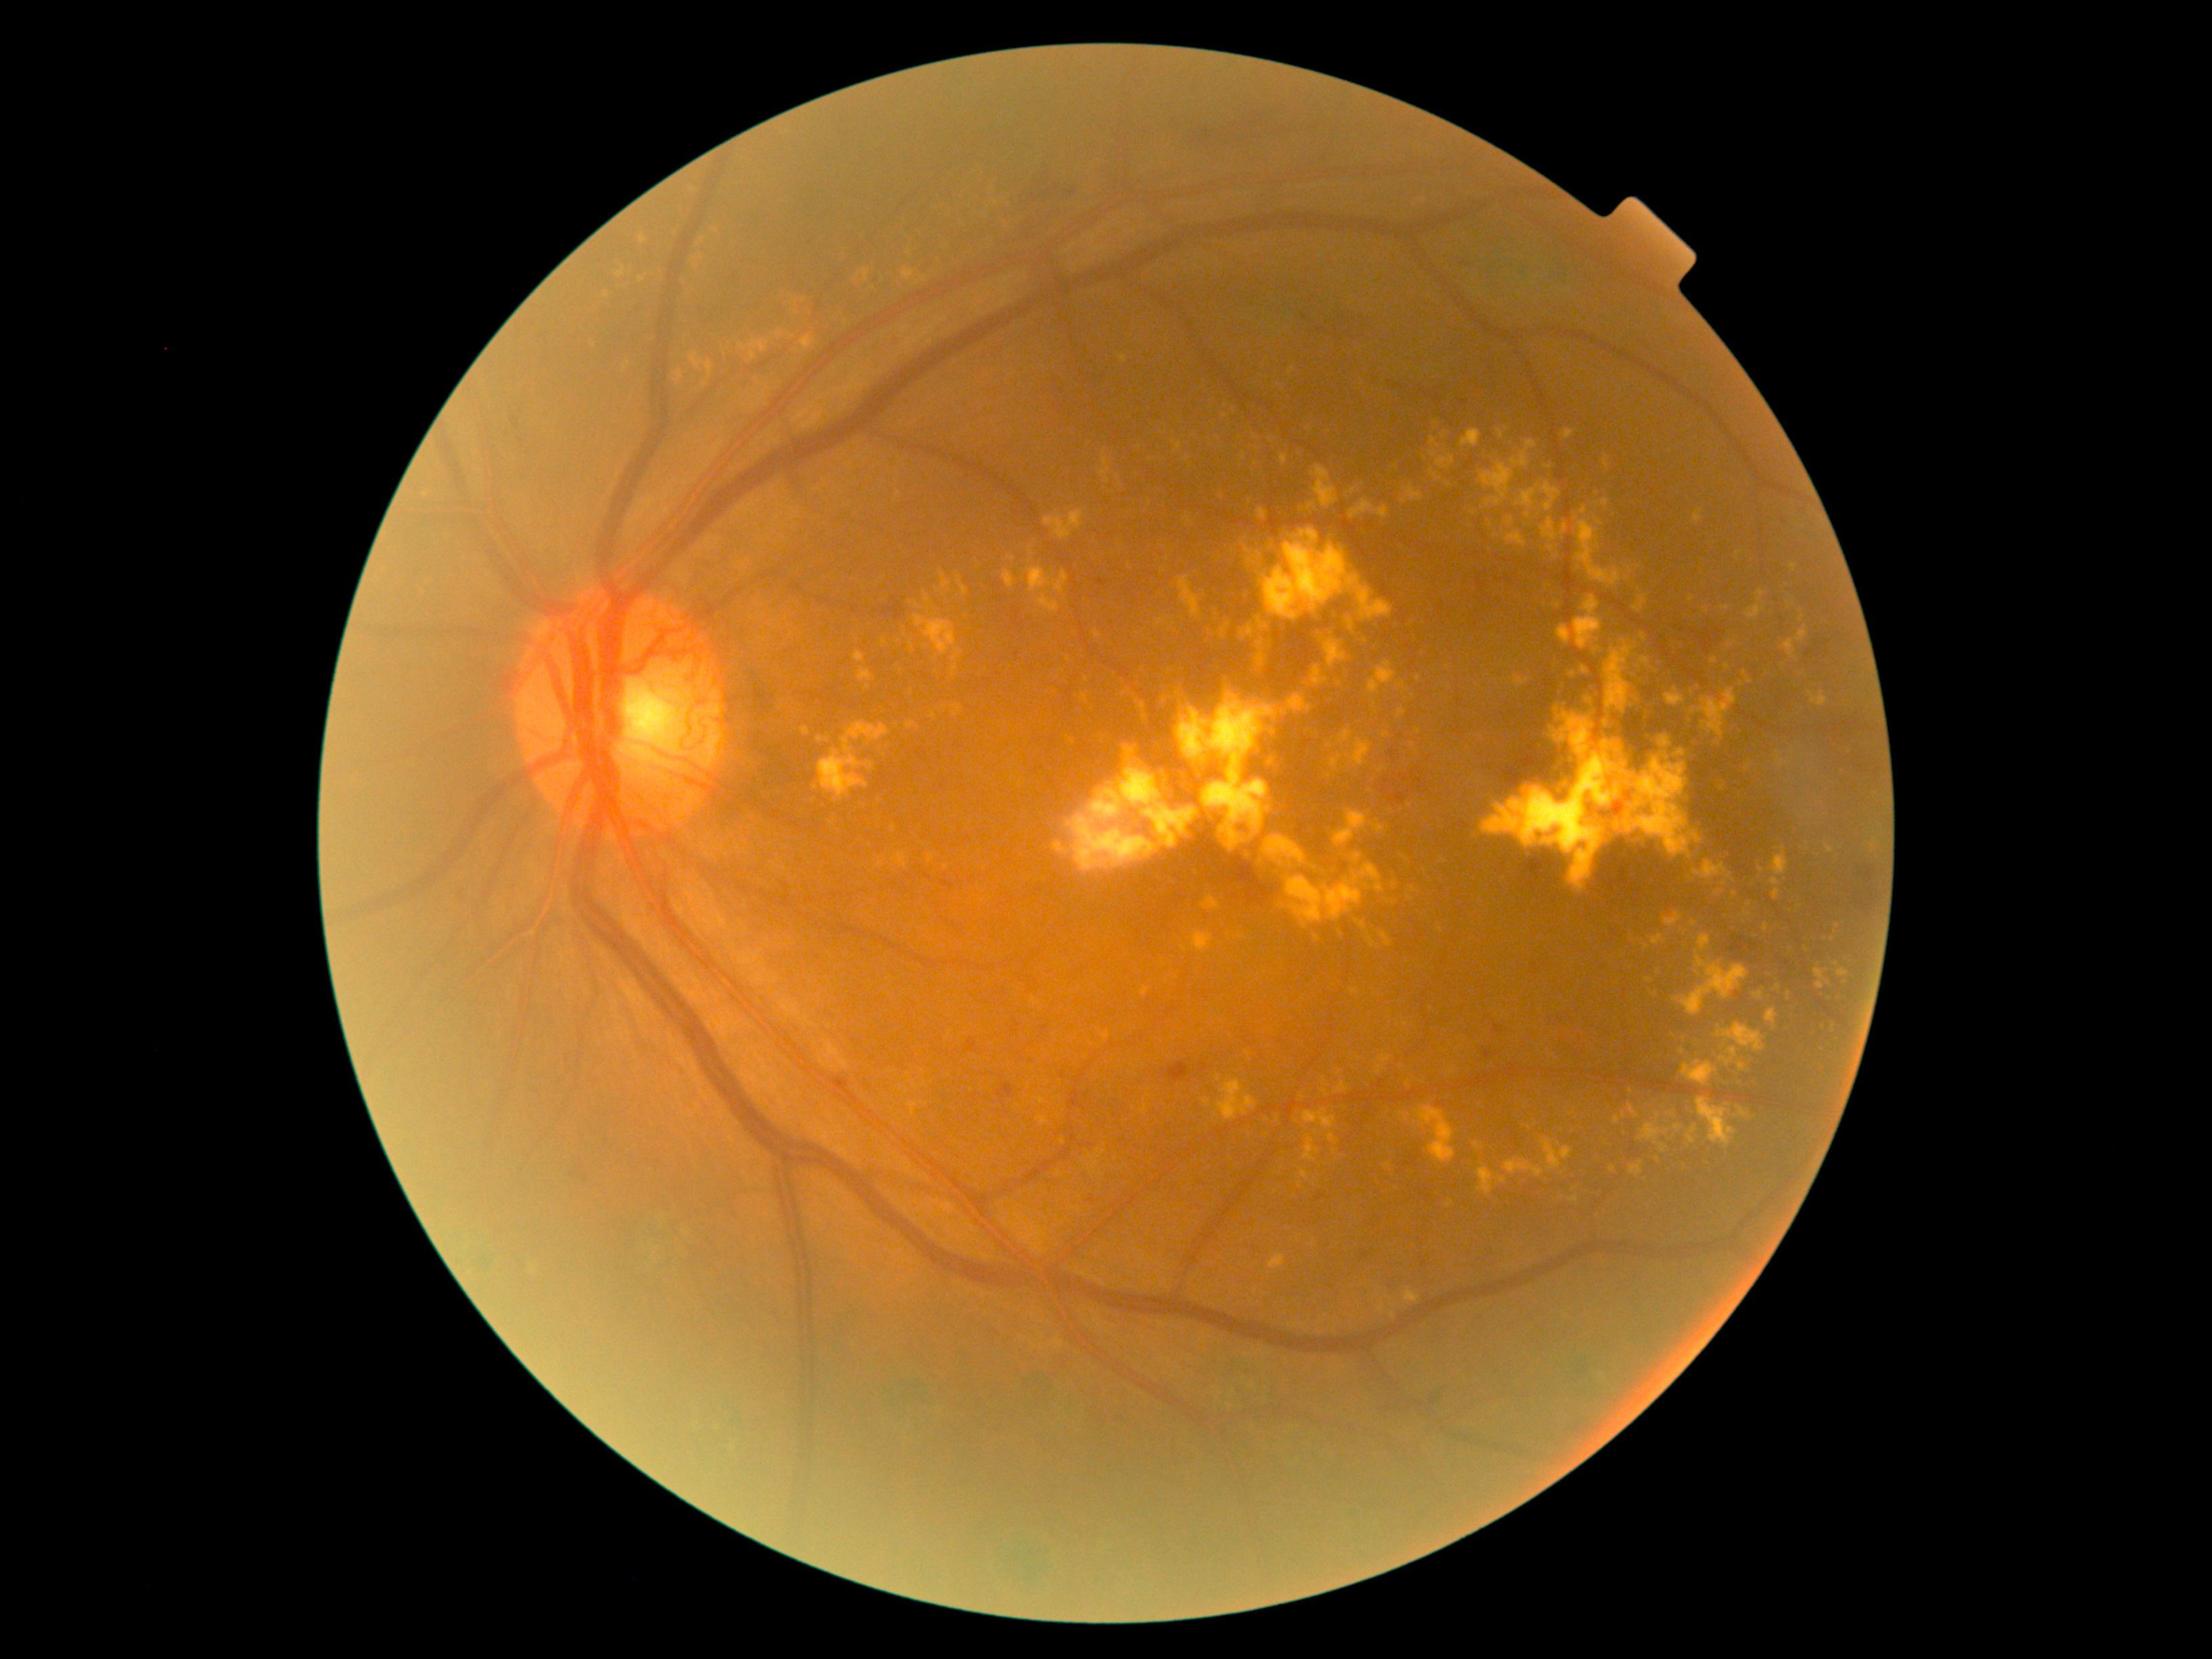

Diabetic retinopathy (DR) is proliferative diabetic retinopathy (grade 4) — neovascularization and/or vitreous/pre-retinal hemorrhage
Selected lesions:
- hard exudates (EXs) (more not shown): region(1772, 890, 1782, 899) | region(1744, 1057, 1750, 1065) | region(1722, 605, 1730, 611) | region(1692, 688, 1738, 741) | region(1155, 617, 1169, 628) | region(897, 669, 902, 677) | region(1142, 1104, 1149, 1115) | region(1765, 1010, 1778, 1033) | region(1474, 1143, 1483, 1150) | region(1367, 661, 1397, 693) | region(1303, 1138, 1321, 1164) | region(802, 335, 815, 350) | region(1173, 440, 1183, 452)
- EXs (small, approximate centers) near pt(1792, 751) | pt(1285, 712) | pt(1683, 1052) | pt(1613, 1169) | pt(1063, 1142) | pt(1338, 1074) | pt(1353, 491)